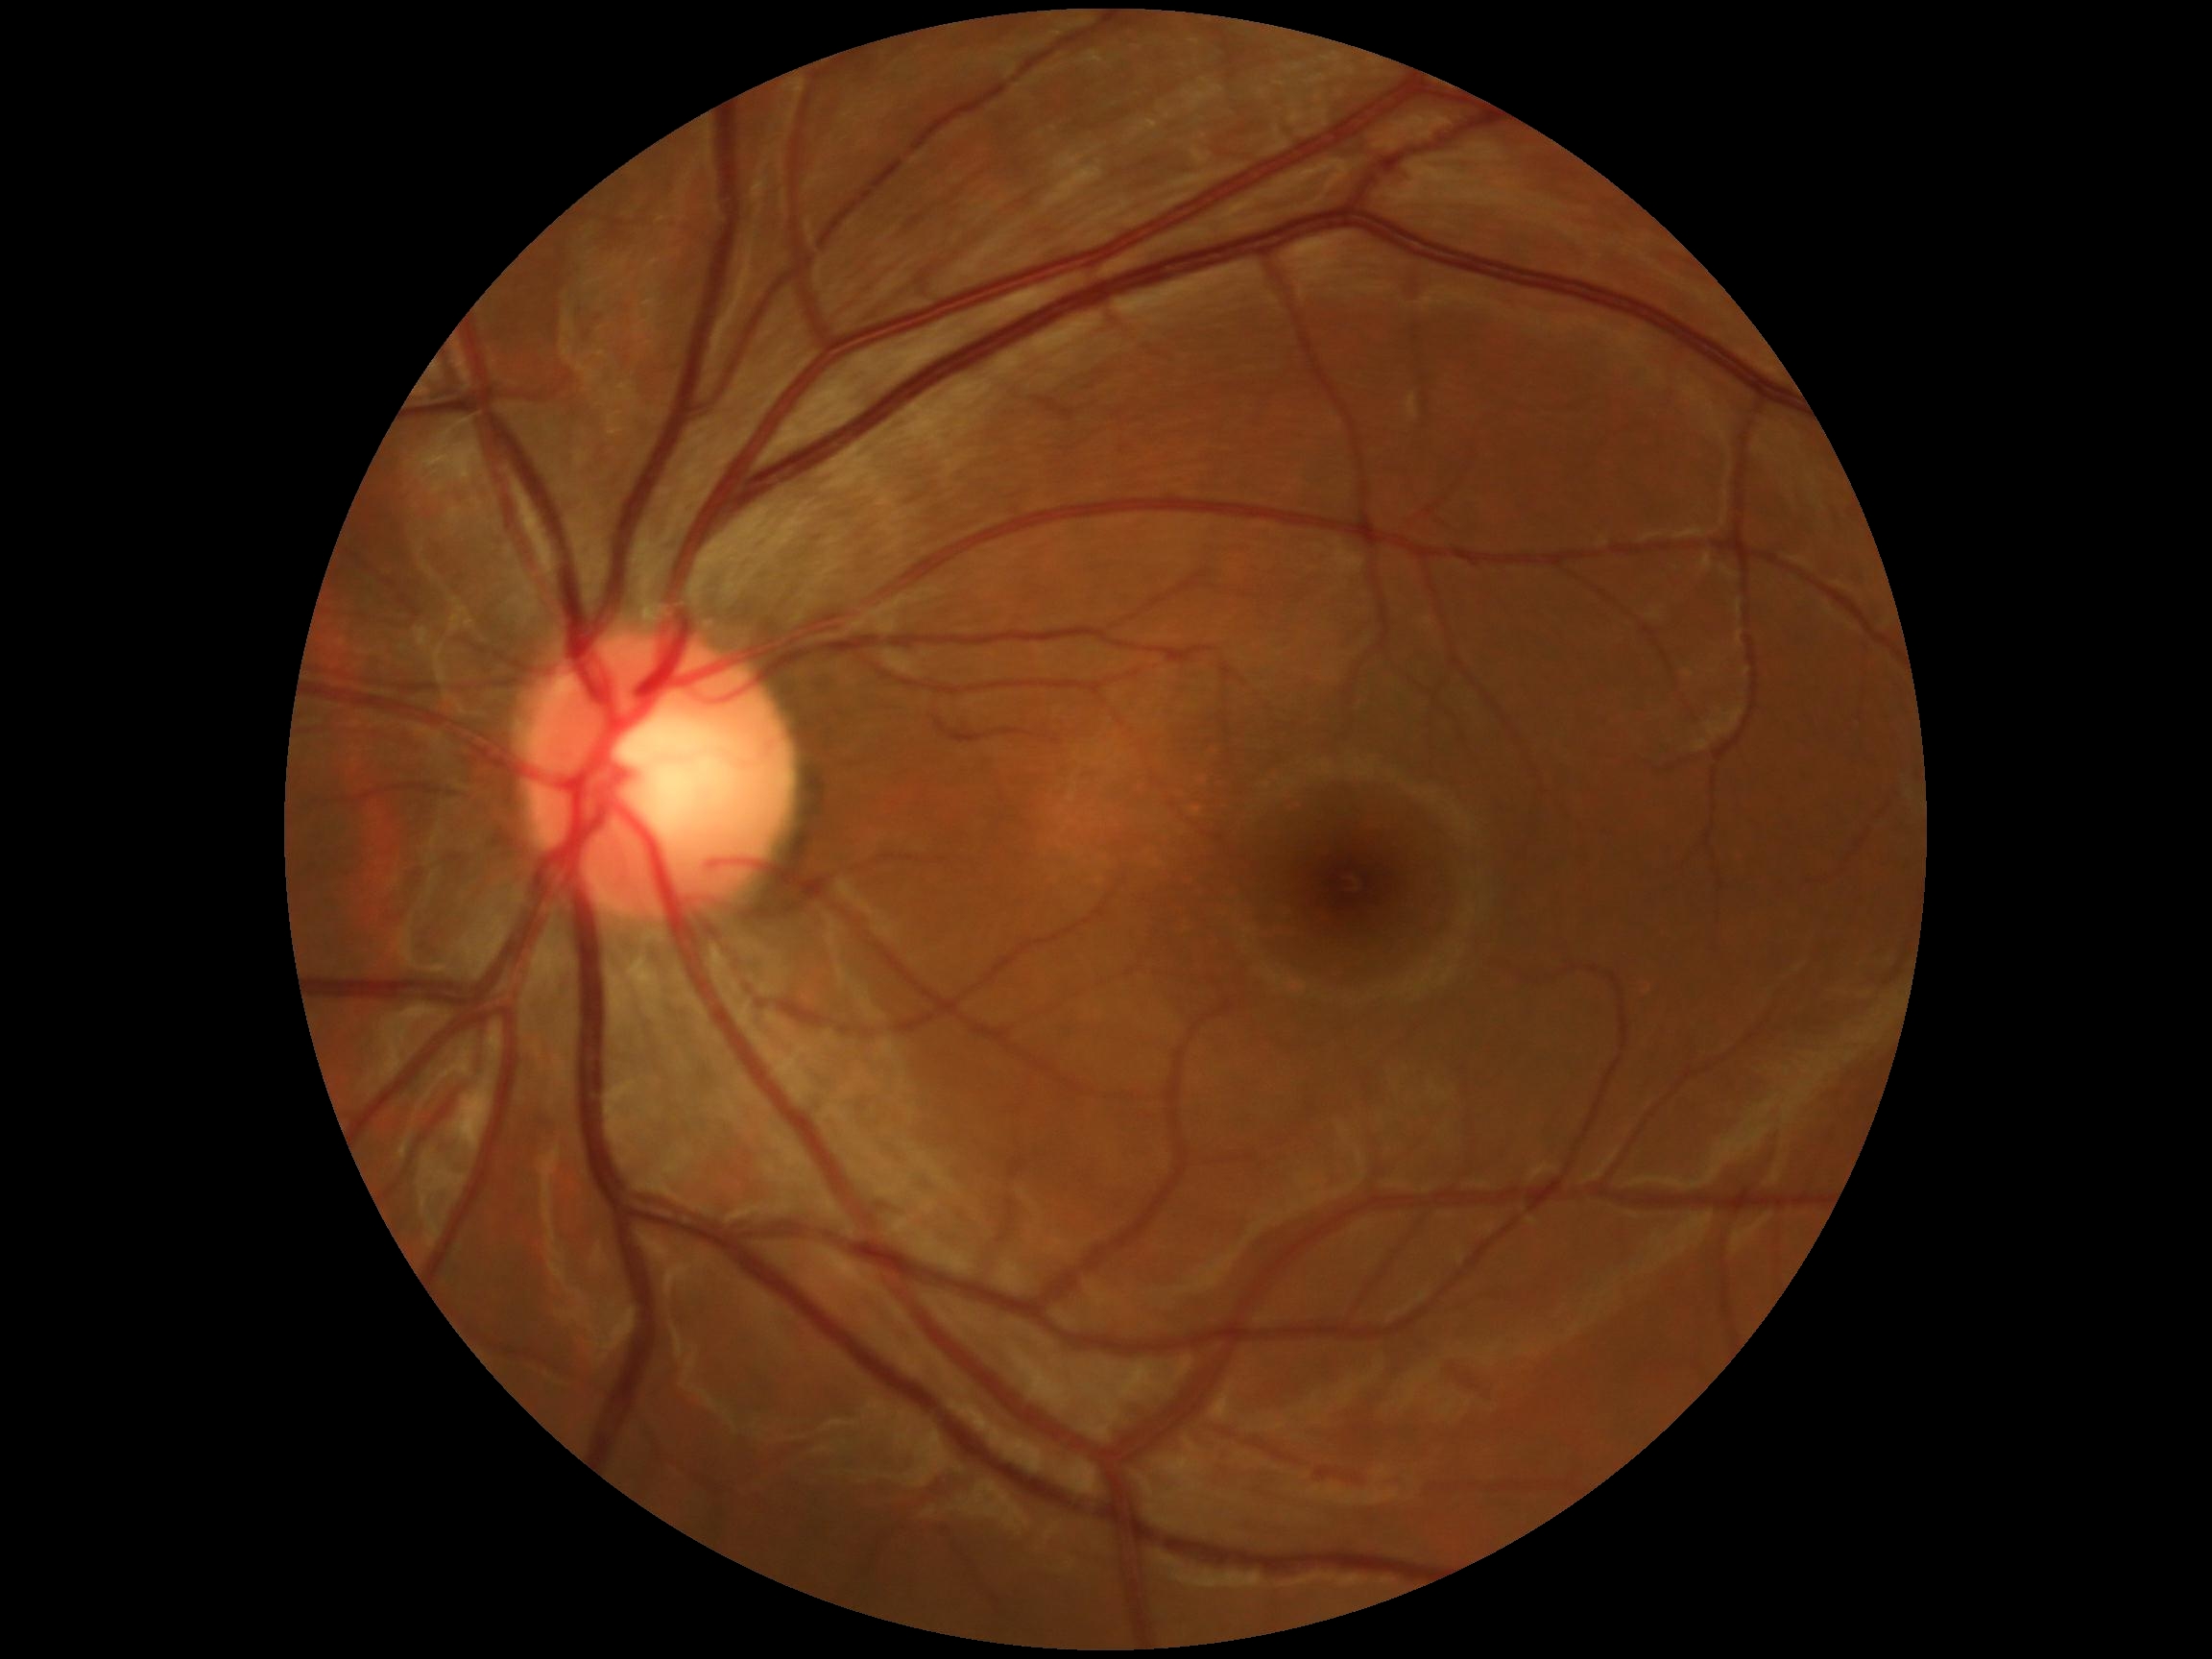 DR severity is grade 0.